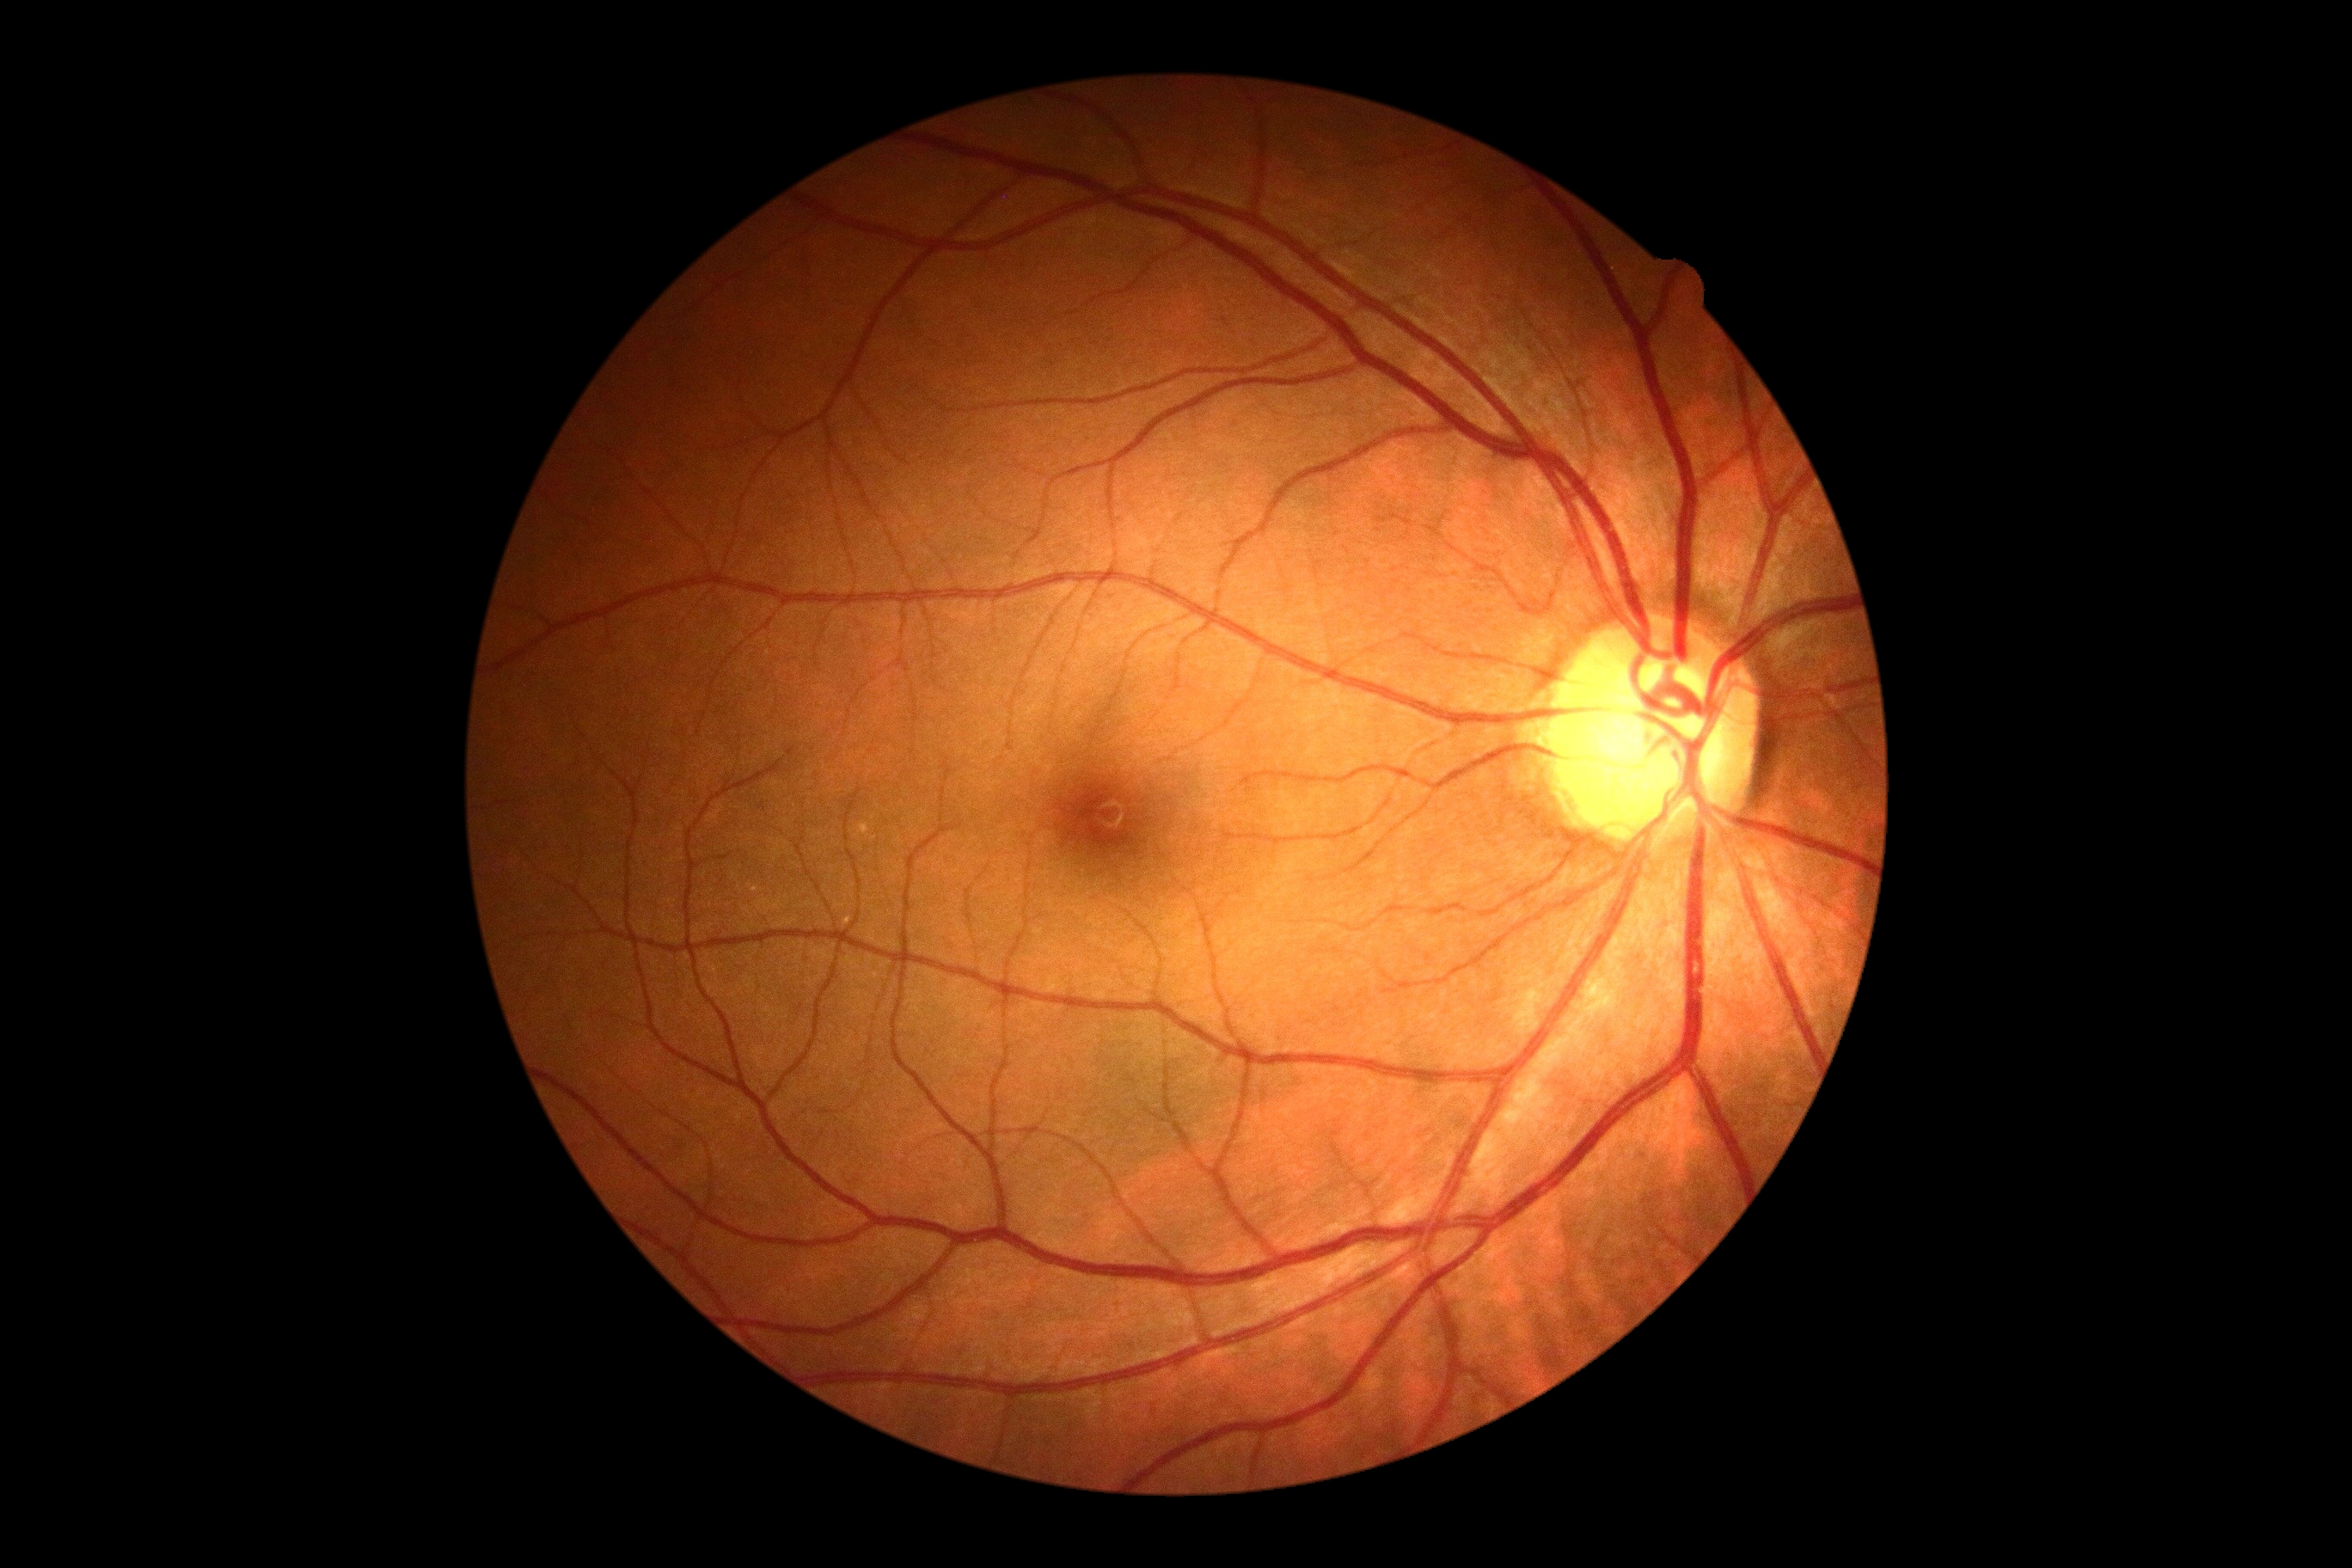
diabetic retinopathy (DR): no apparent retinopathy (grade 0) — no visible signs of diabetic retinopathy.